50-degree field of view. 2361 by 1568 pixels — 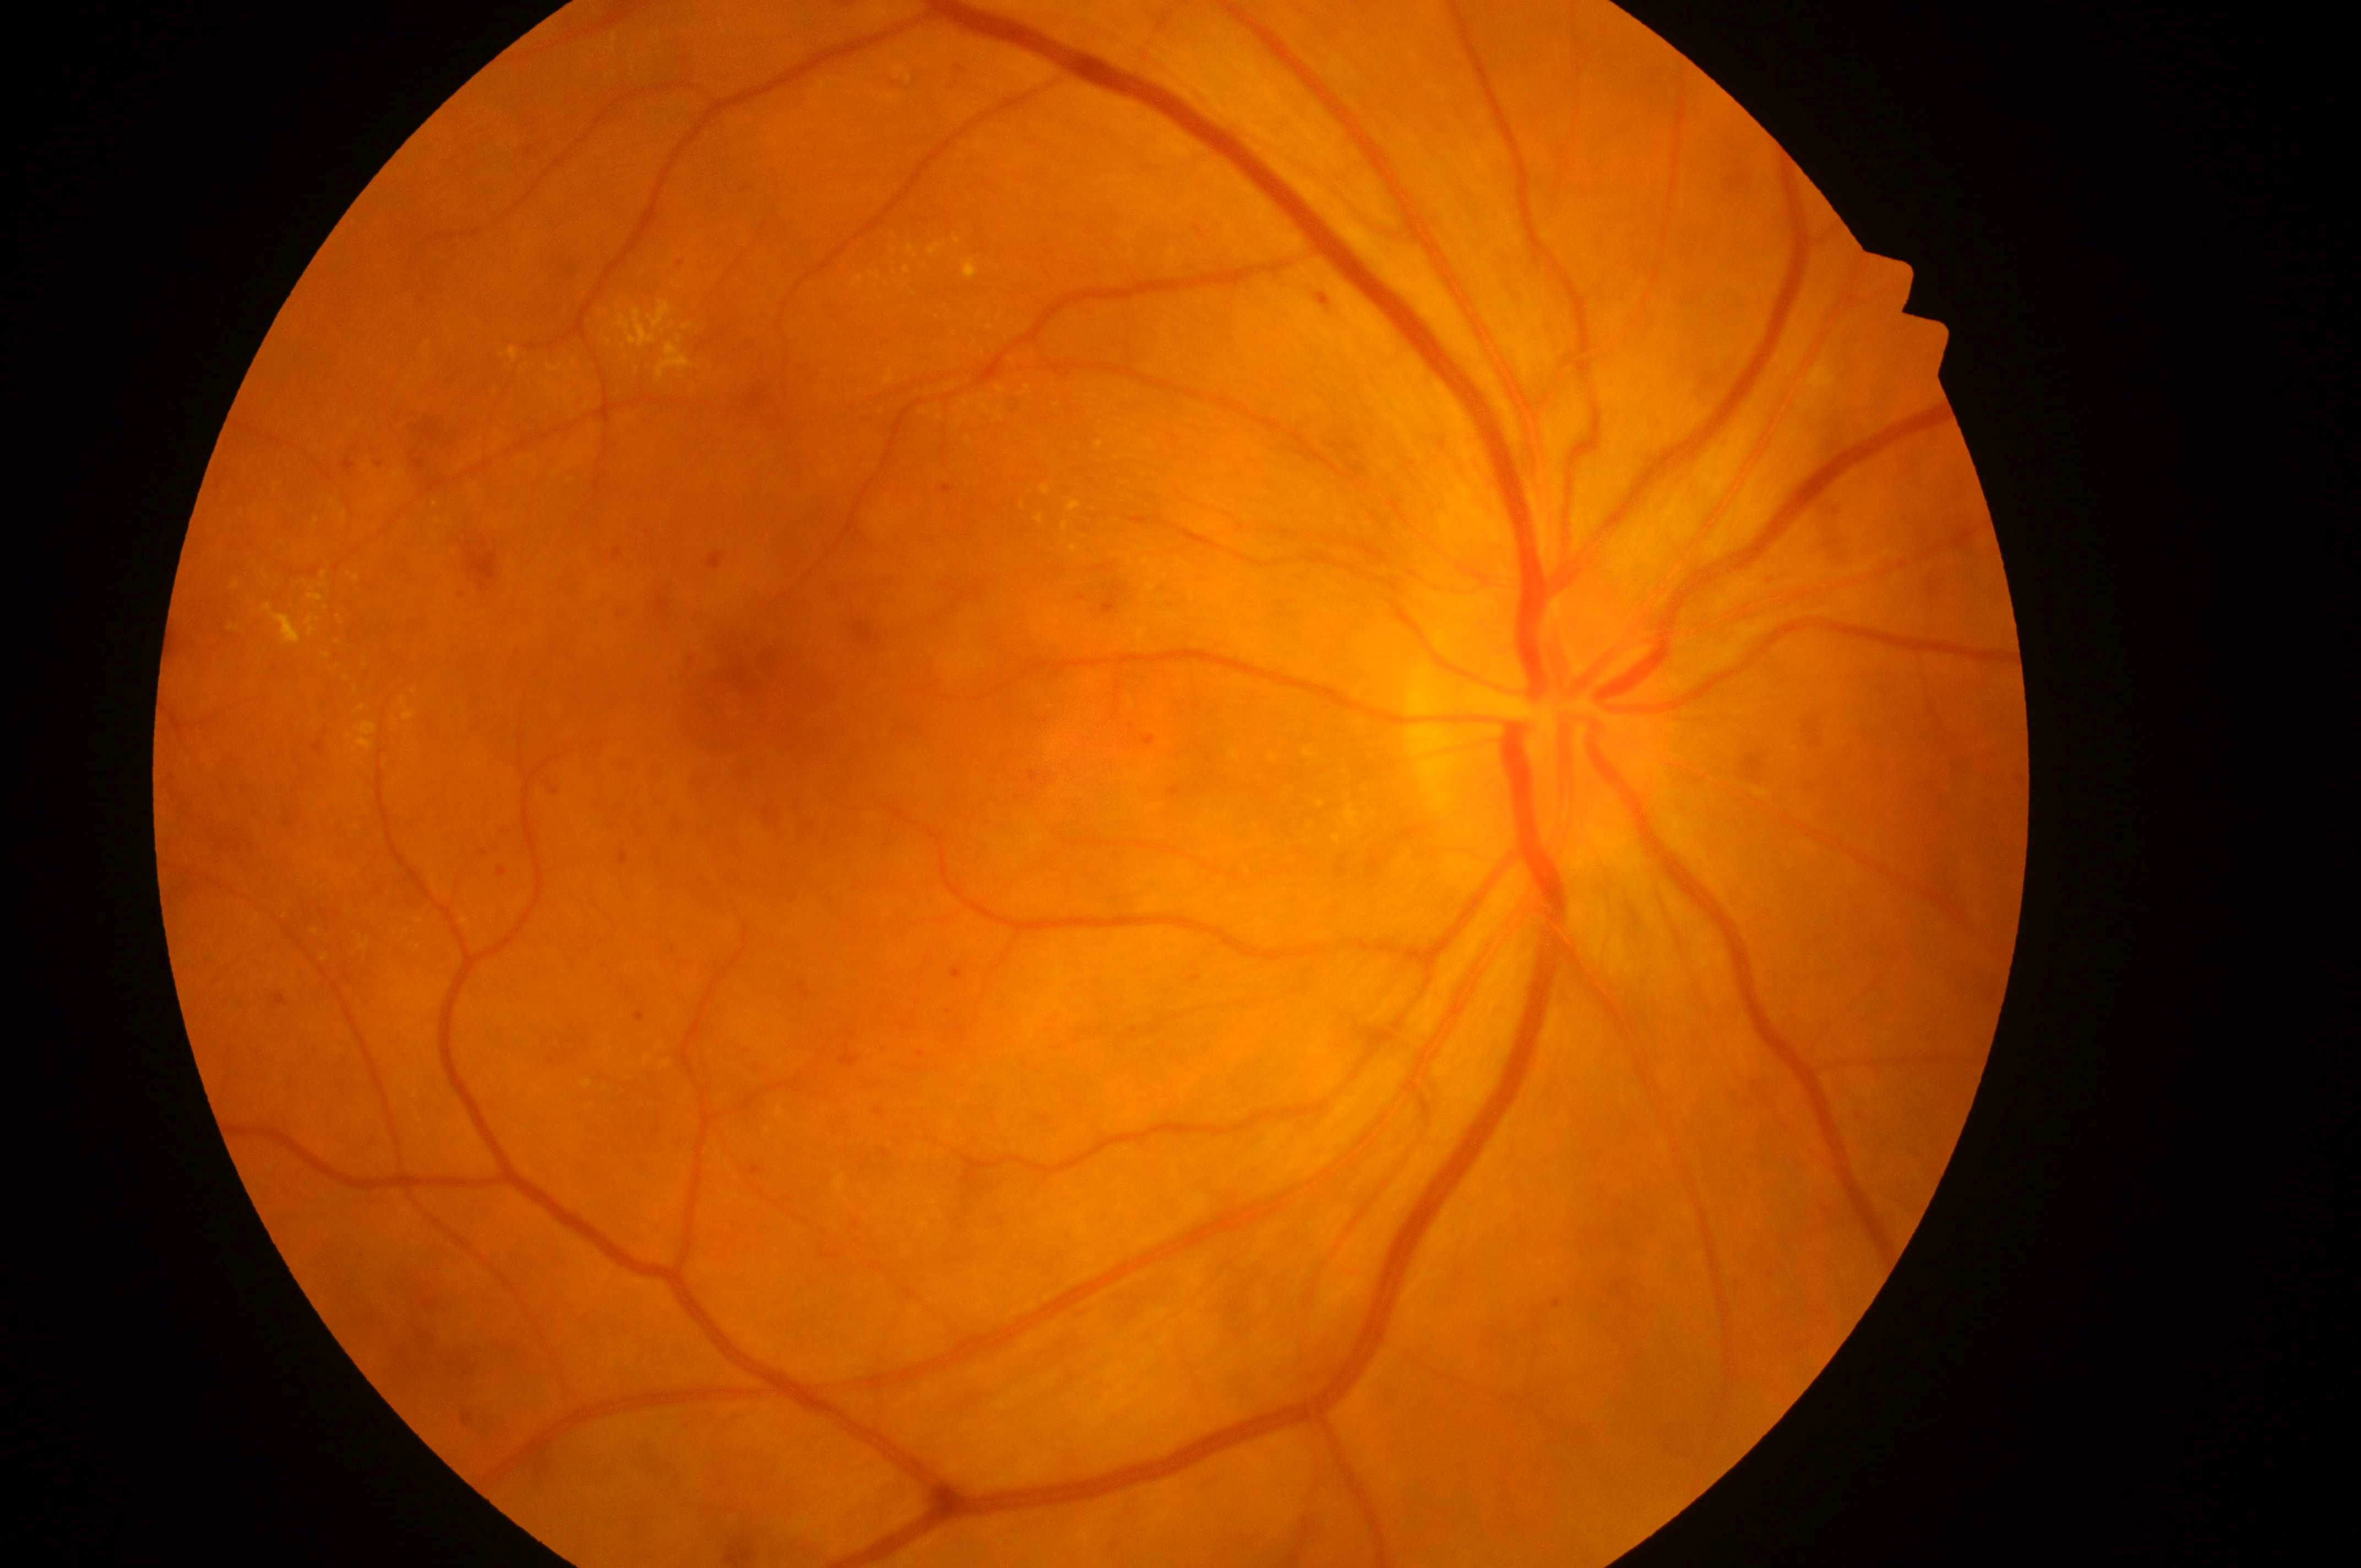

DME grade is 1 (low risk). DR severity: moderate NPDR (grade 2). Eye: OD. Fovea: 753, 684. Disc center: 1531, 723. DR class: non-proliferative diabetic retinopathy.